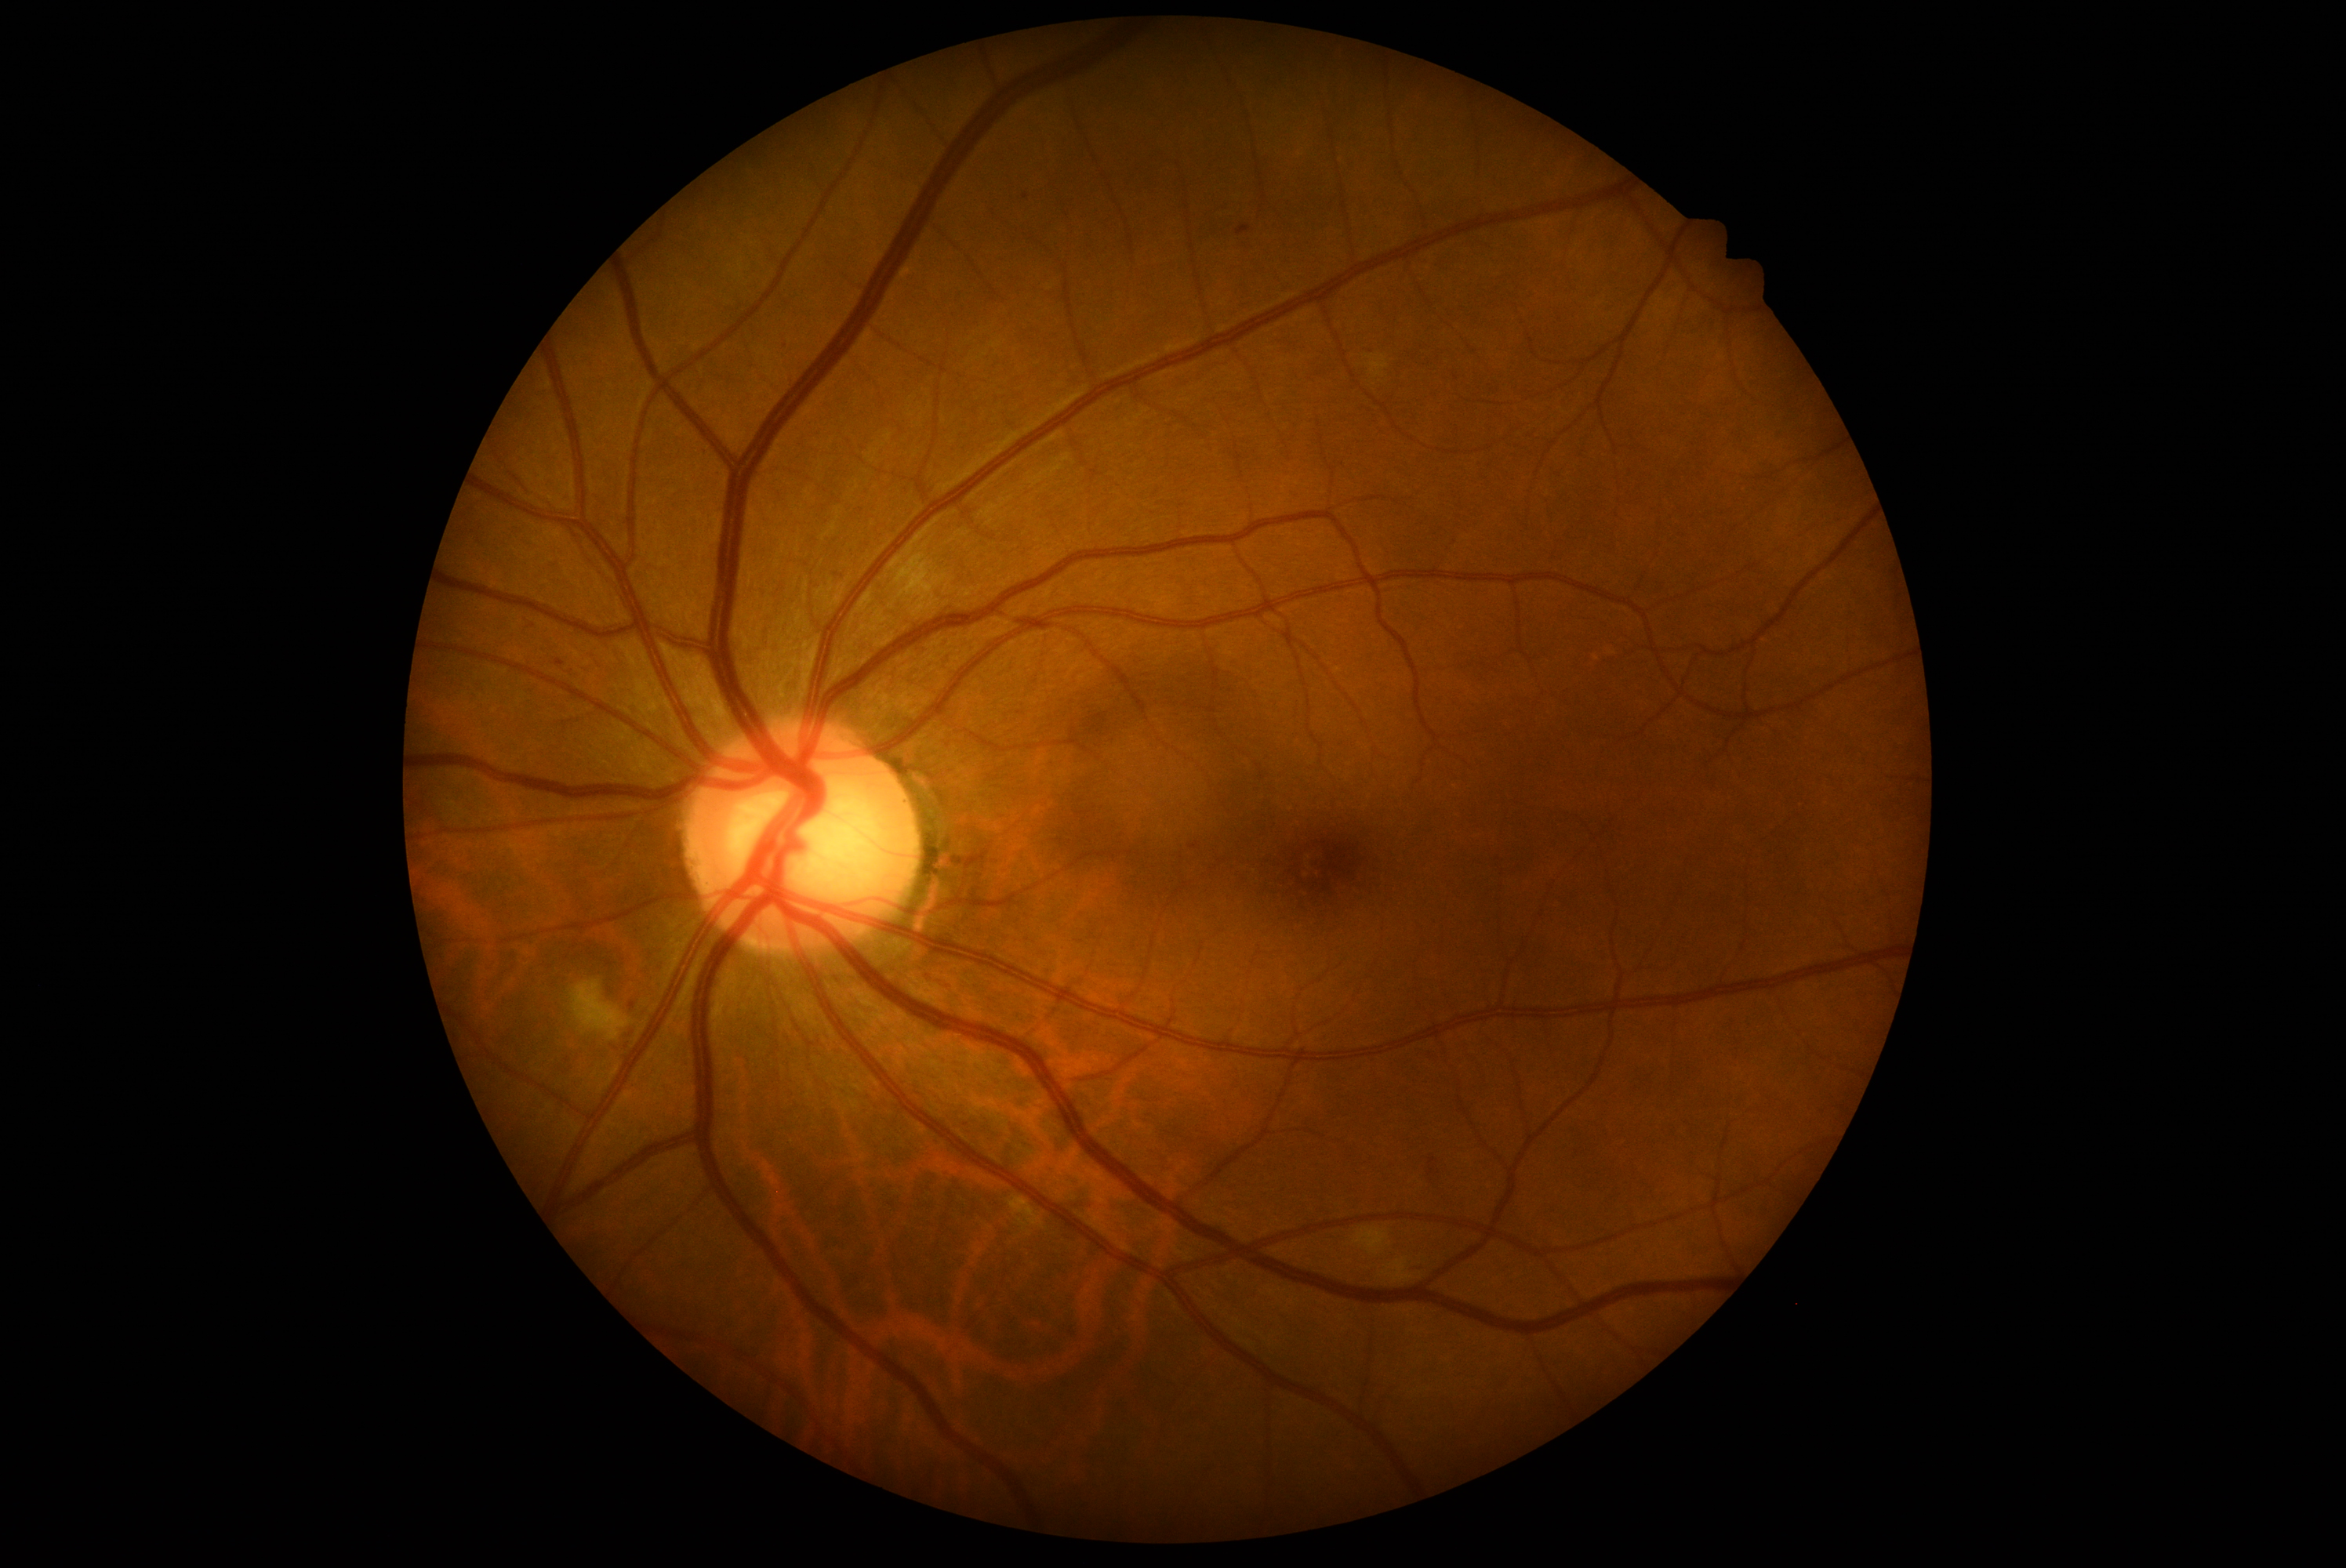

Disease class: non-proliferative diabetic retinopathy. DR stage: 2/4 — more than just microaneurysms but less than severe NPDR.